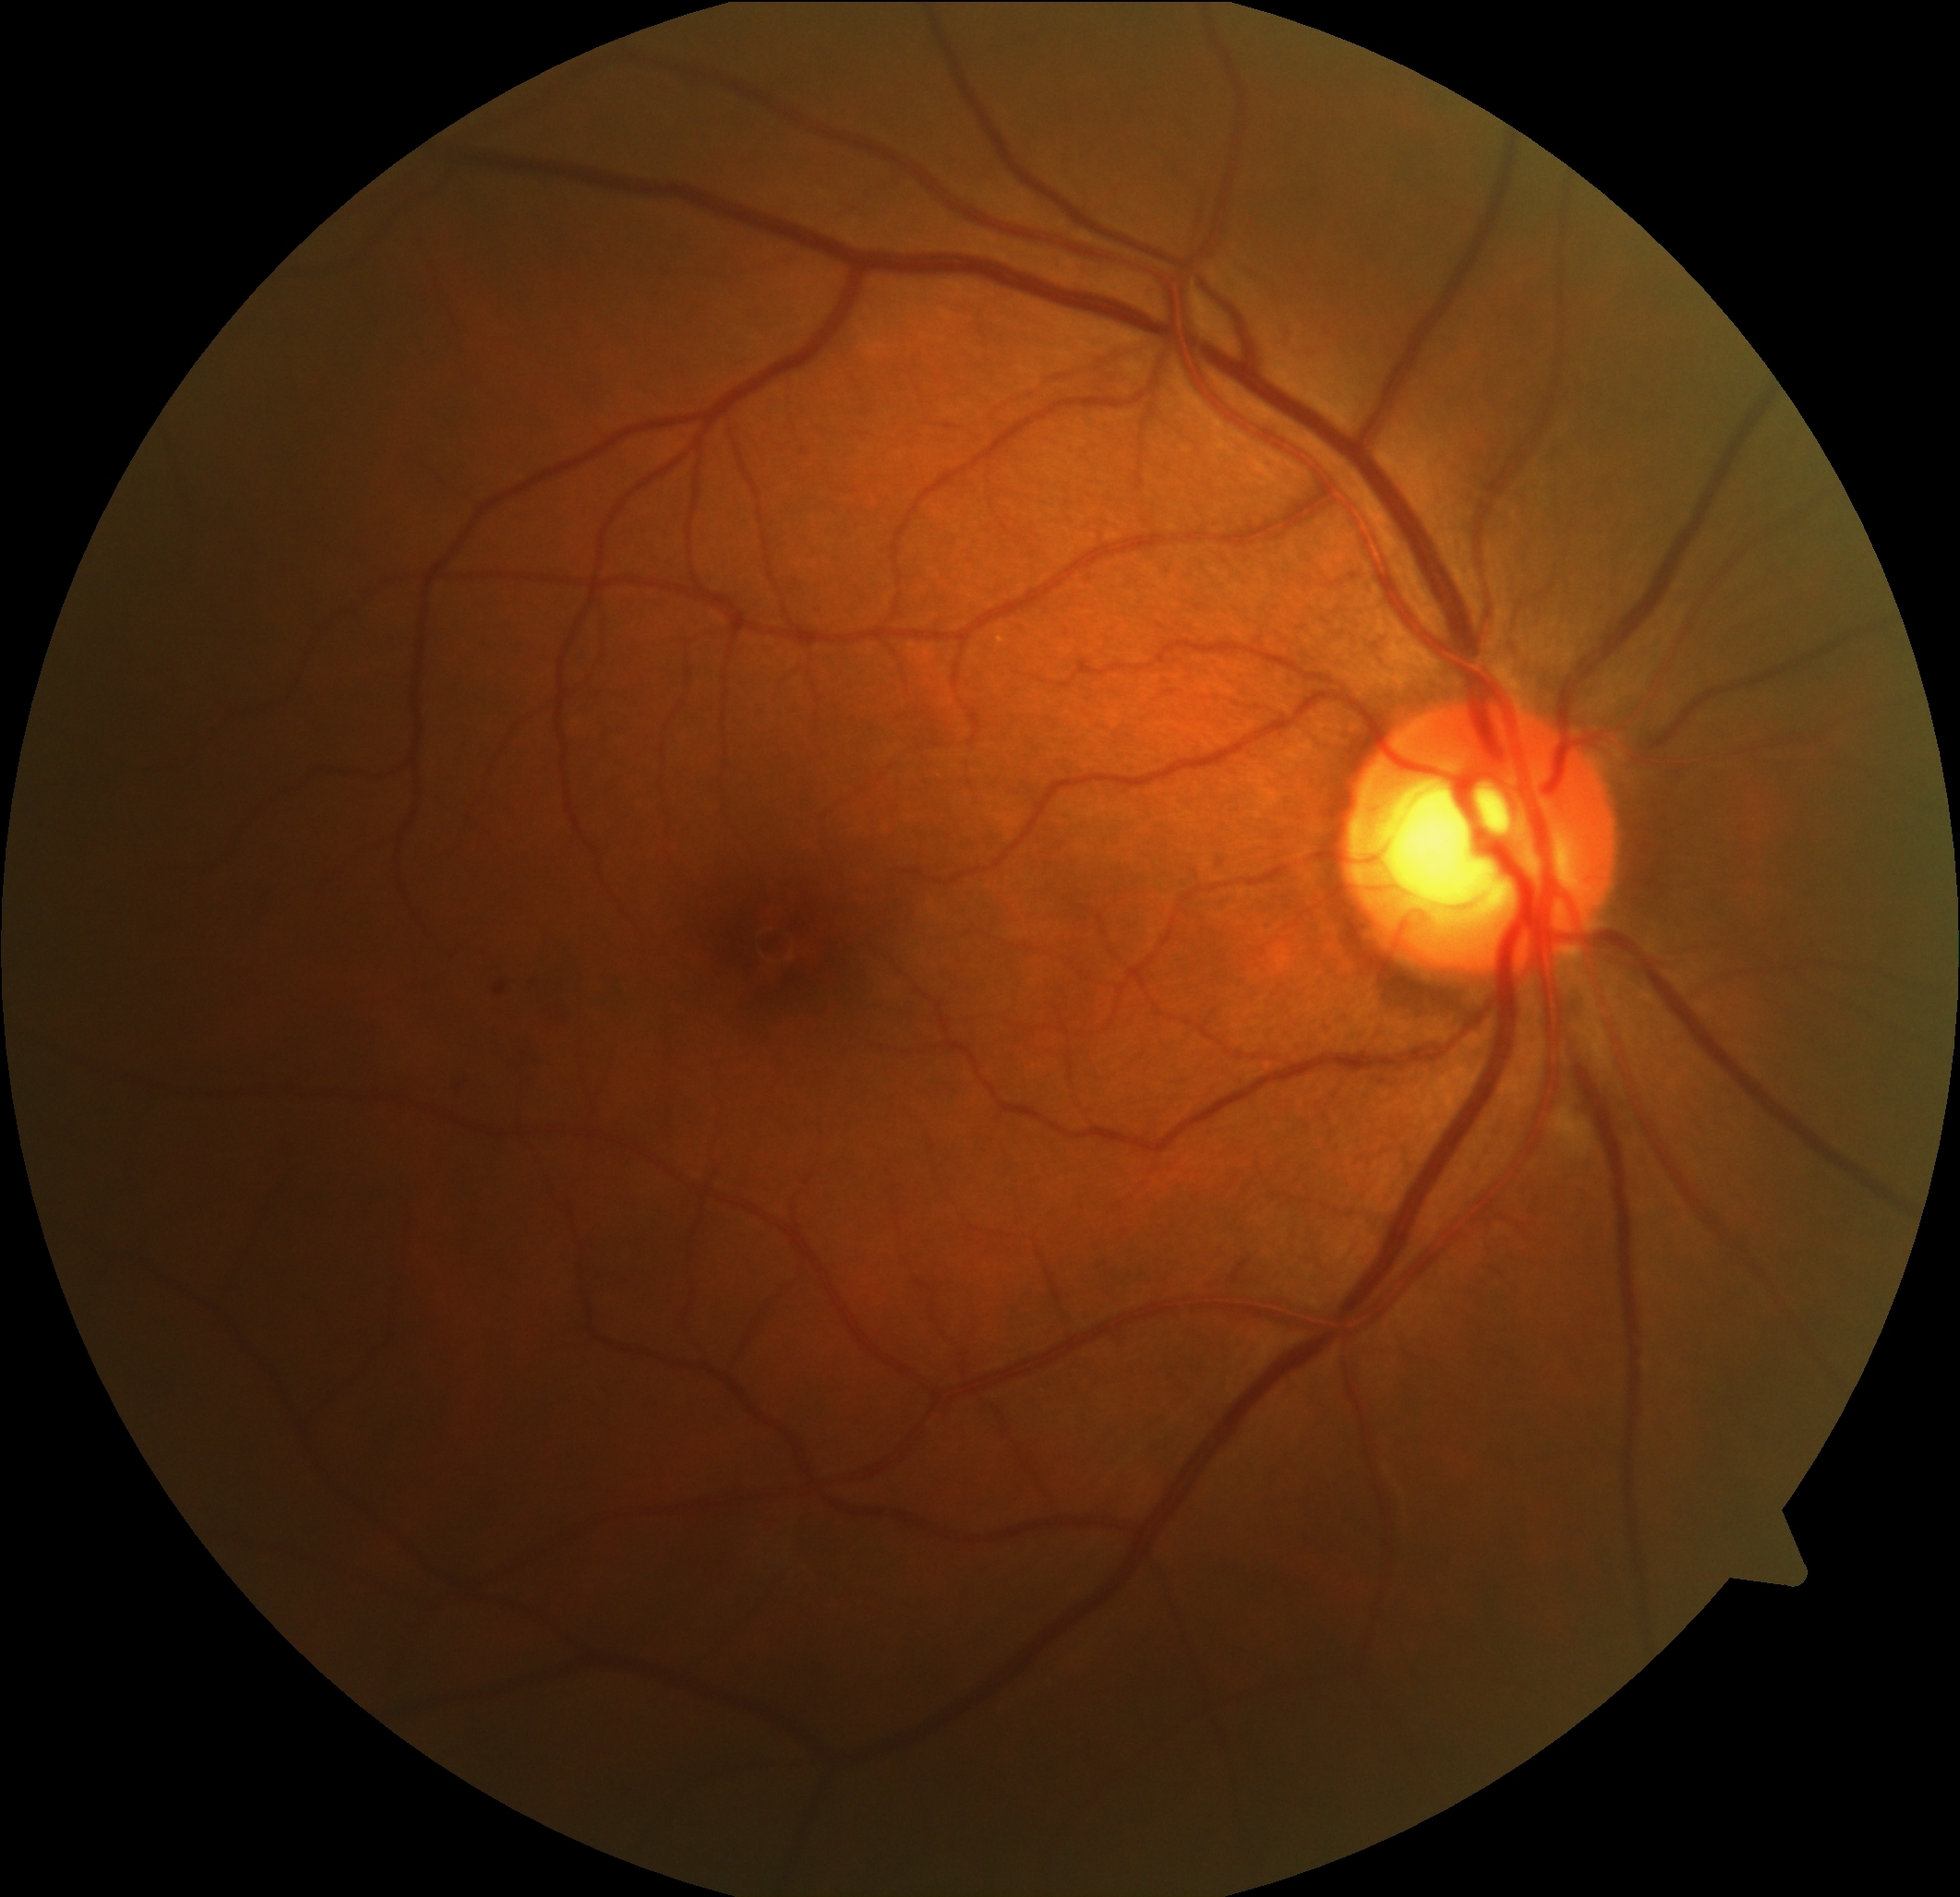

Diabetic retinopathy (DR): grade 2 (moderate NPDR).